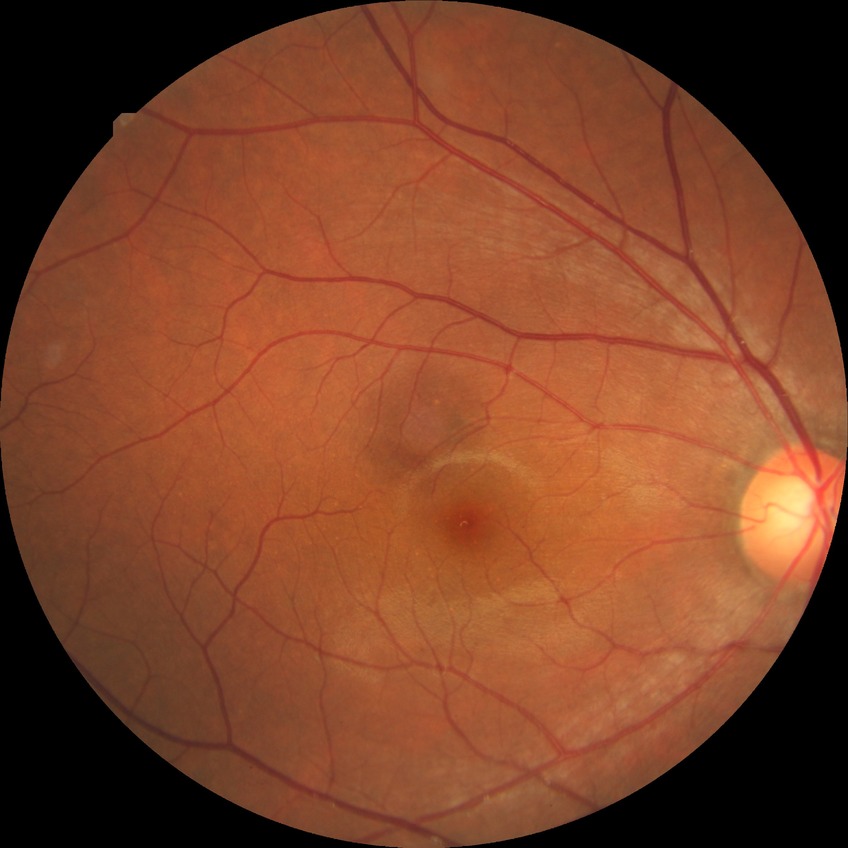 diabetic retinopathy (DR): NDR (no diabetic retinopathy).